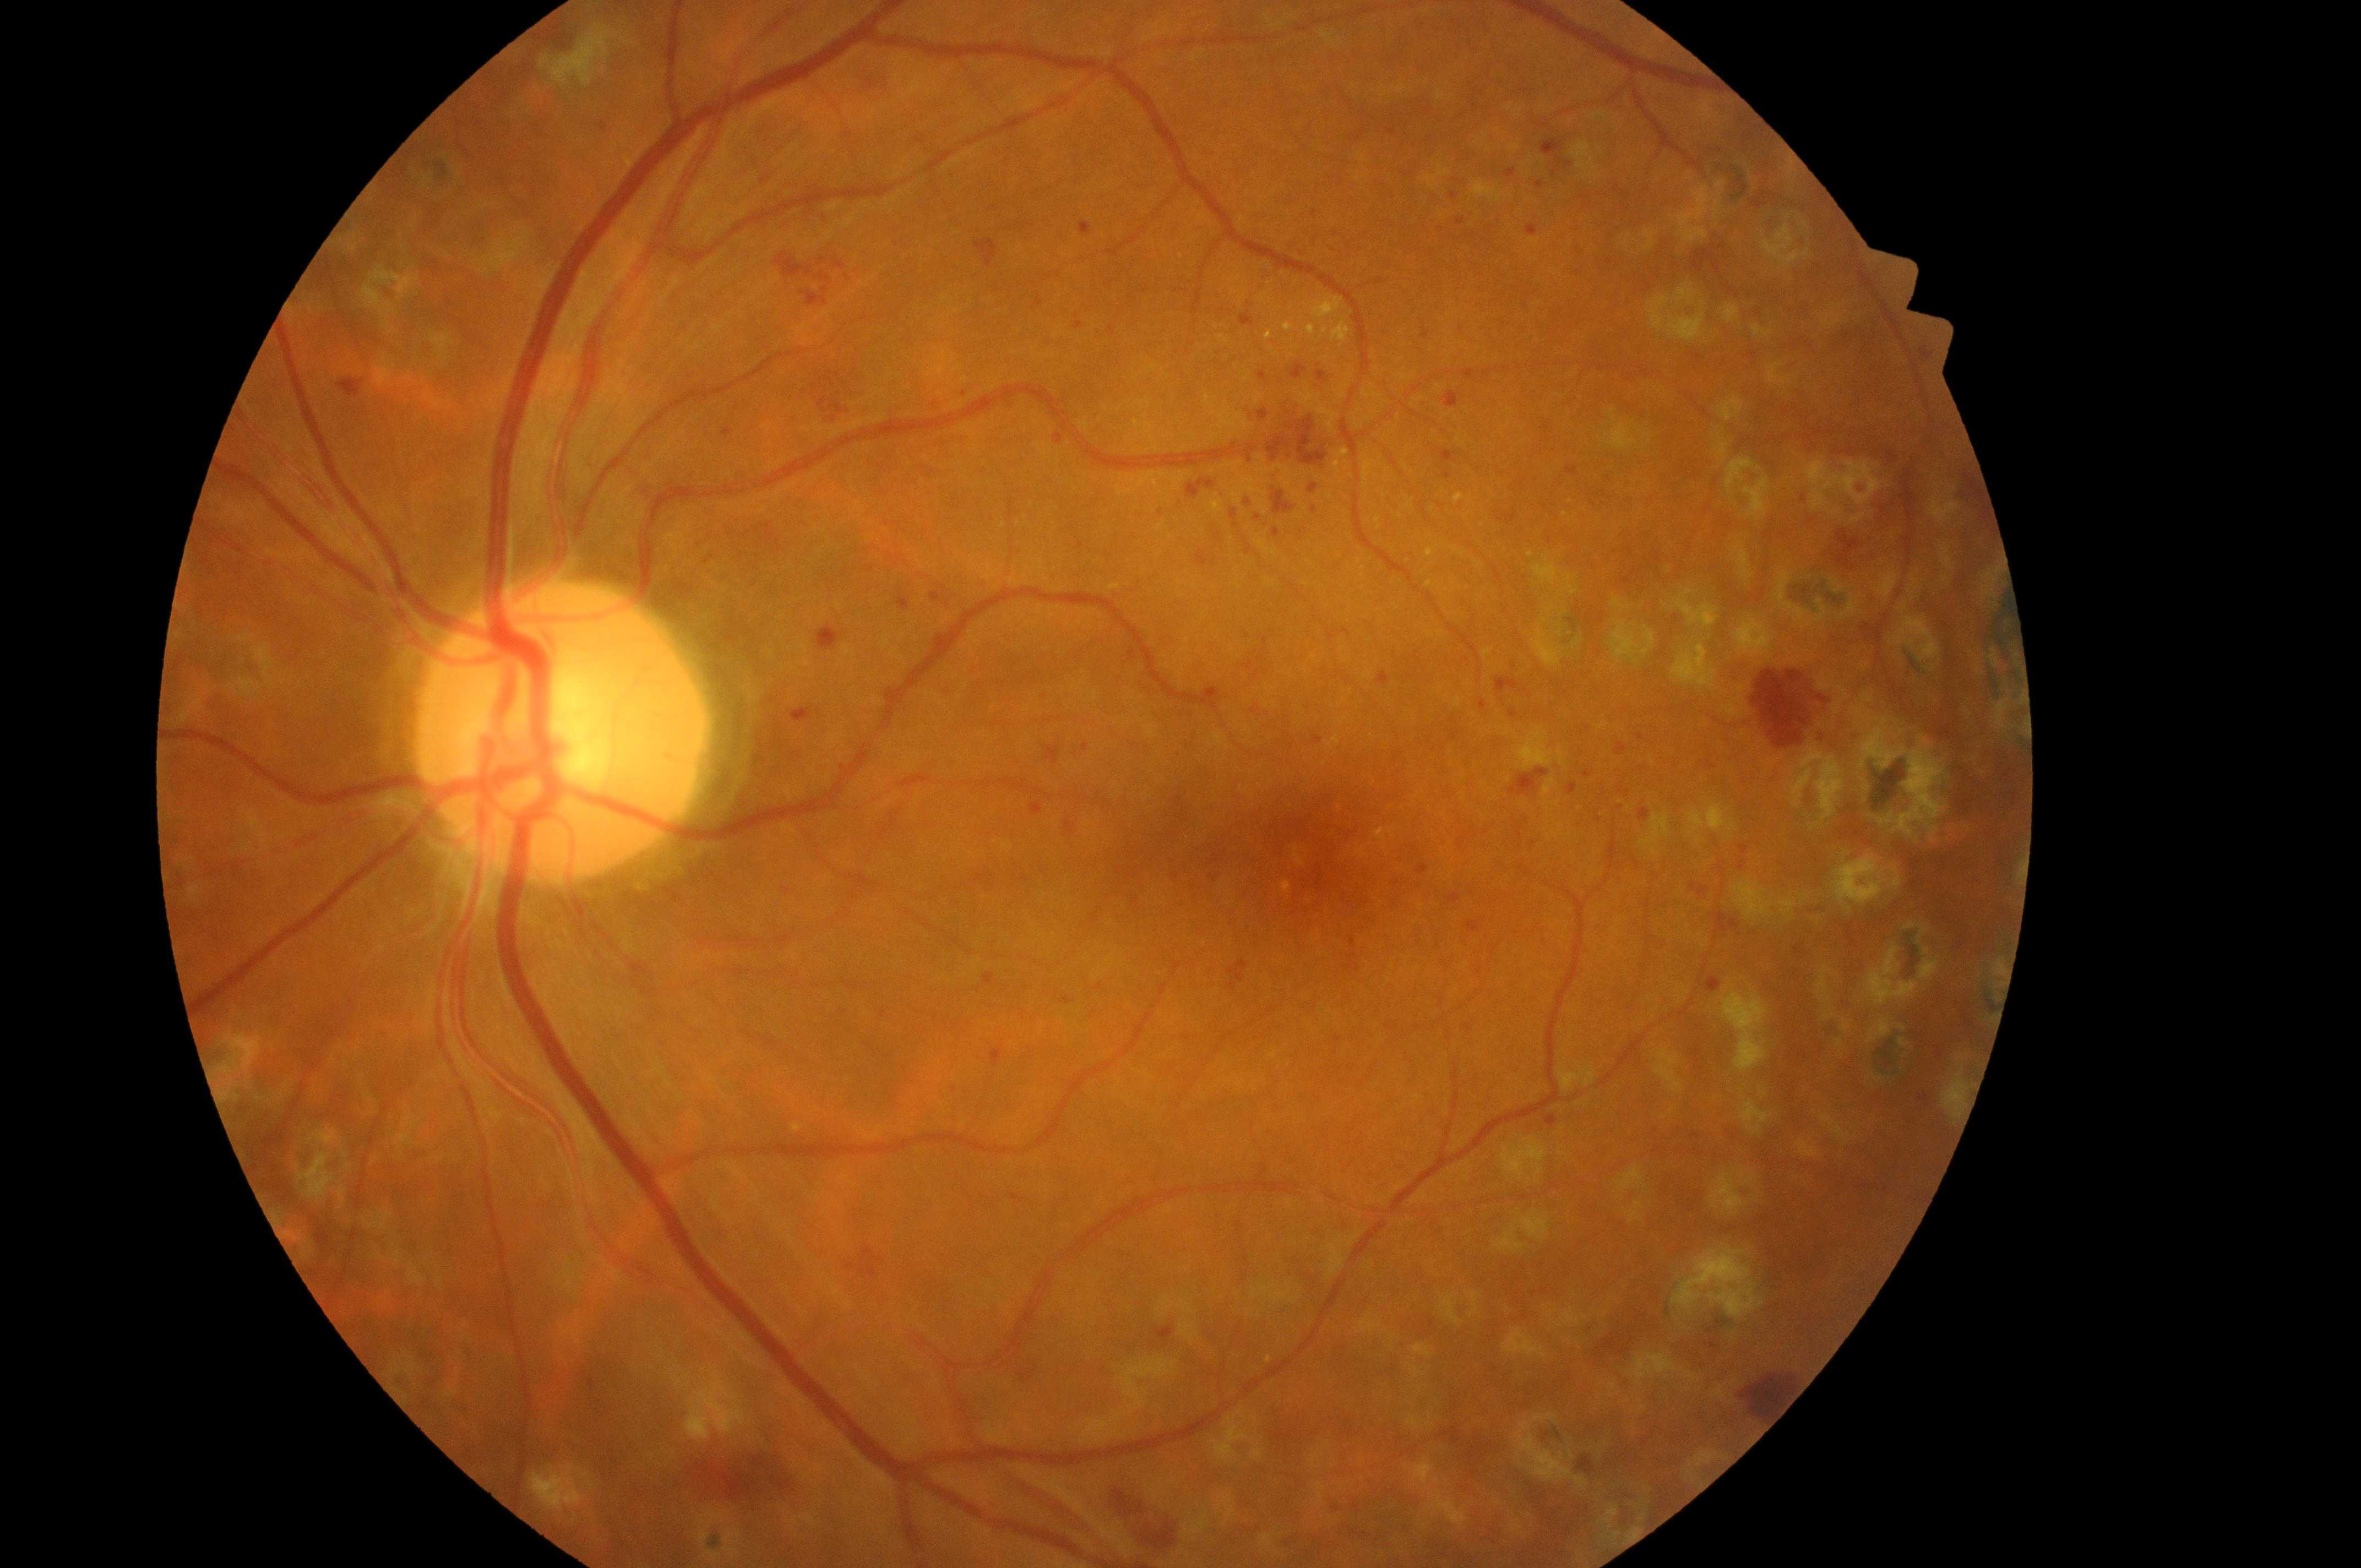

{
  "dr_grade": "3 (severe NPDR)",
  "fovea": "1314, 872",
  "optic_disc": "554, 742",
  "dme_grade": "2 (high risk)",
  "eye": "oculus sinister"
}